240x240px: 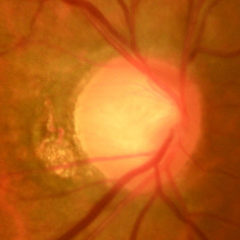 Glaucomatous optic neuropathy is present. Diagnosis: early glaucomatous optic neuropathy.